Optic disc region of a color fundus photo: 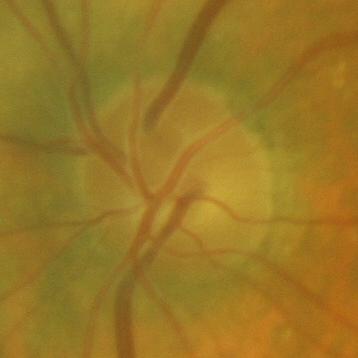 Assessment = no glaucoma.